Wide-field fundus photograph from neonatal ROP screening.
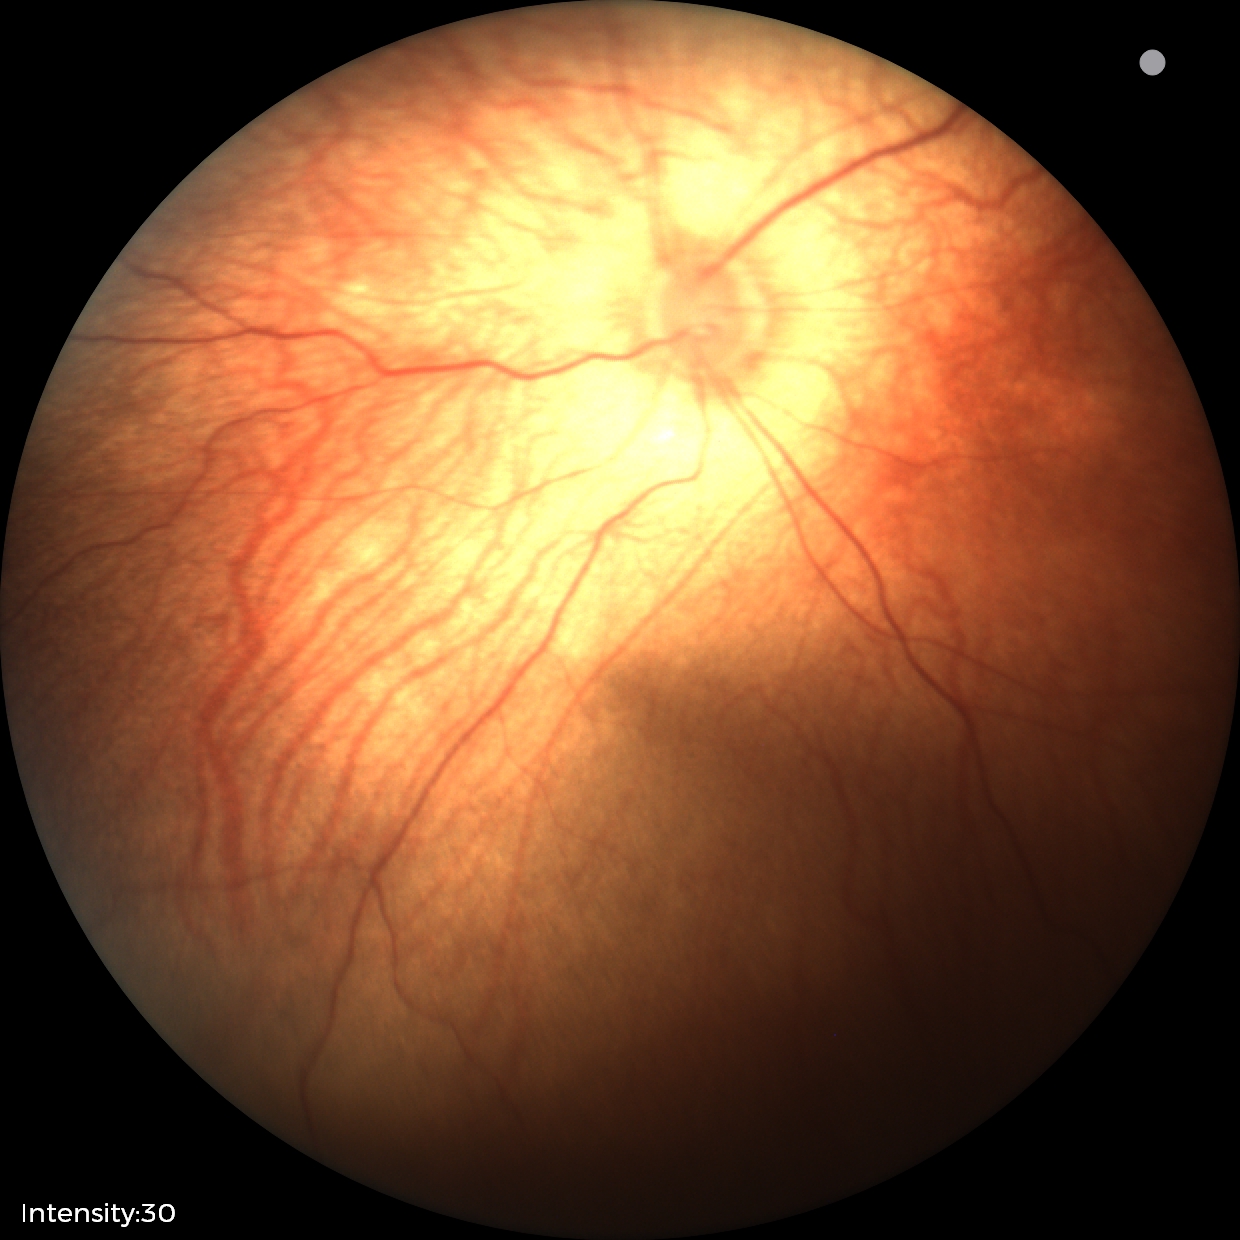
Screening examination diagnosed as physiological.